1659x2212px, Remidio Fundus on Phone (FOP) camera, retinal fundus photograph.
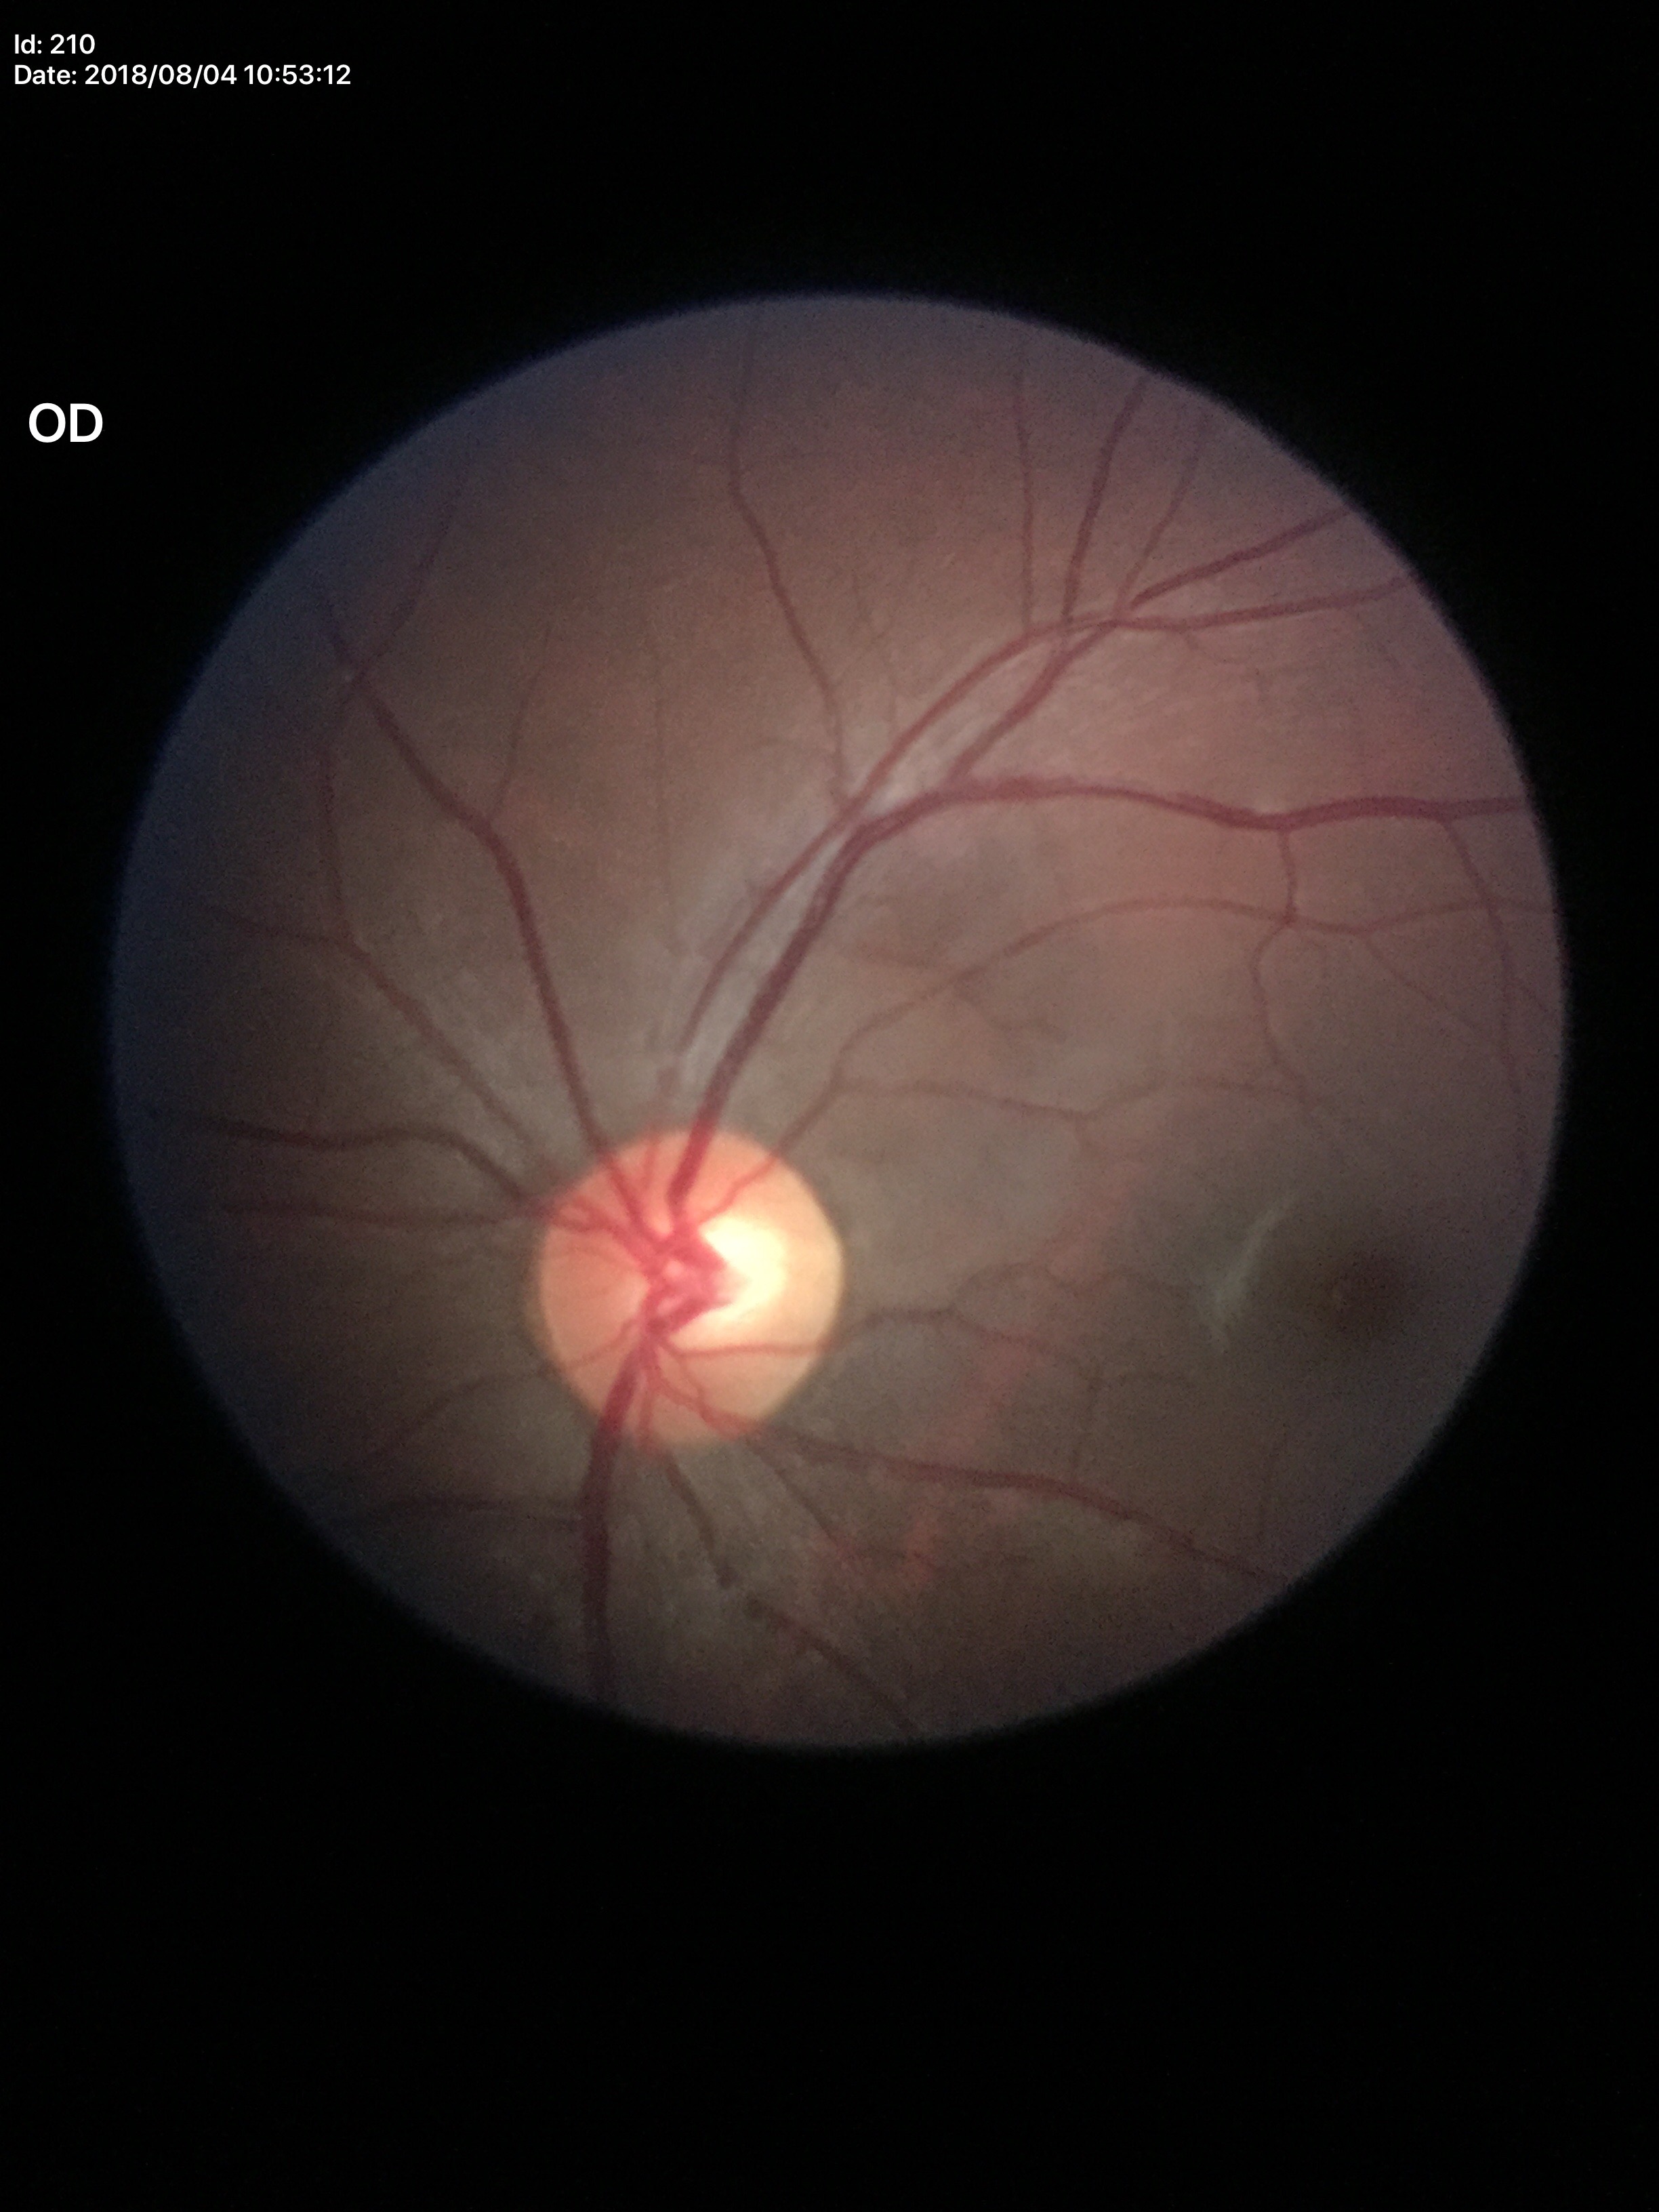
Not suspicious for glaucoma (unanimous normal call).
Vertical C/D ratio (VCDR): 0.50.